2048 by 1536 pixels · FOV: 45 degrees
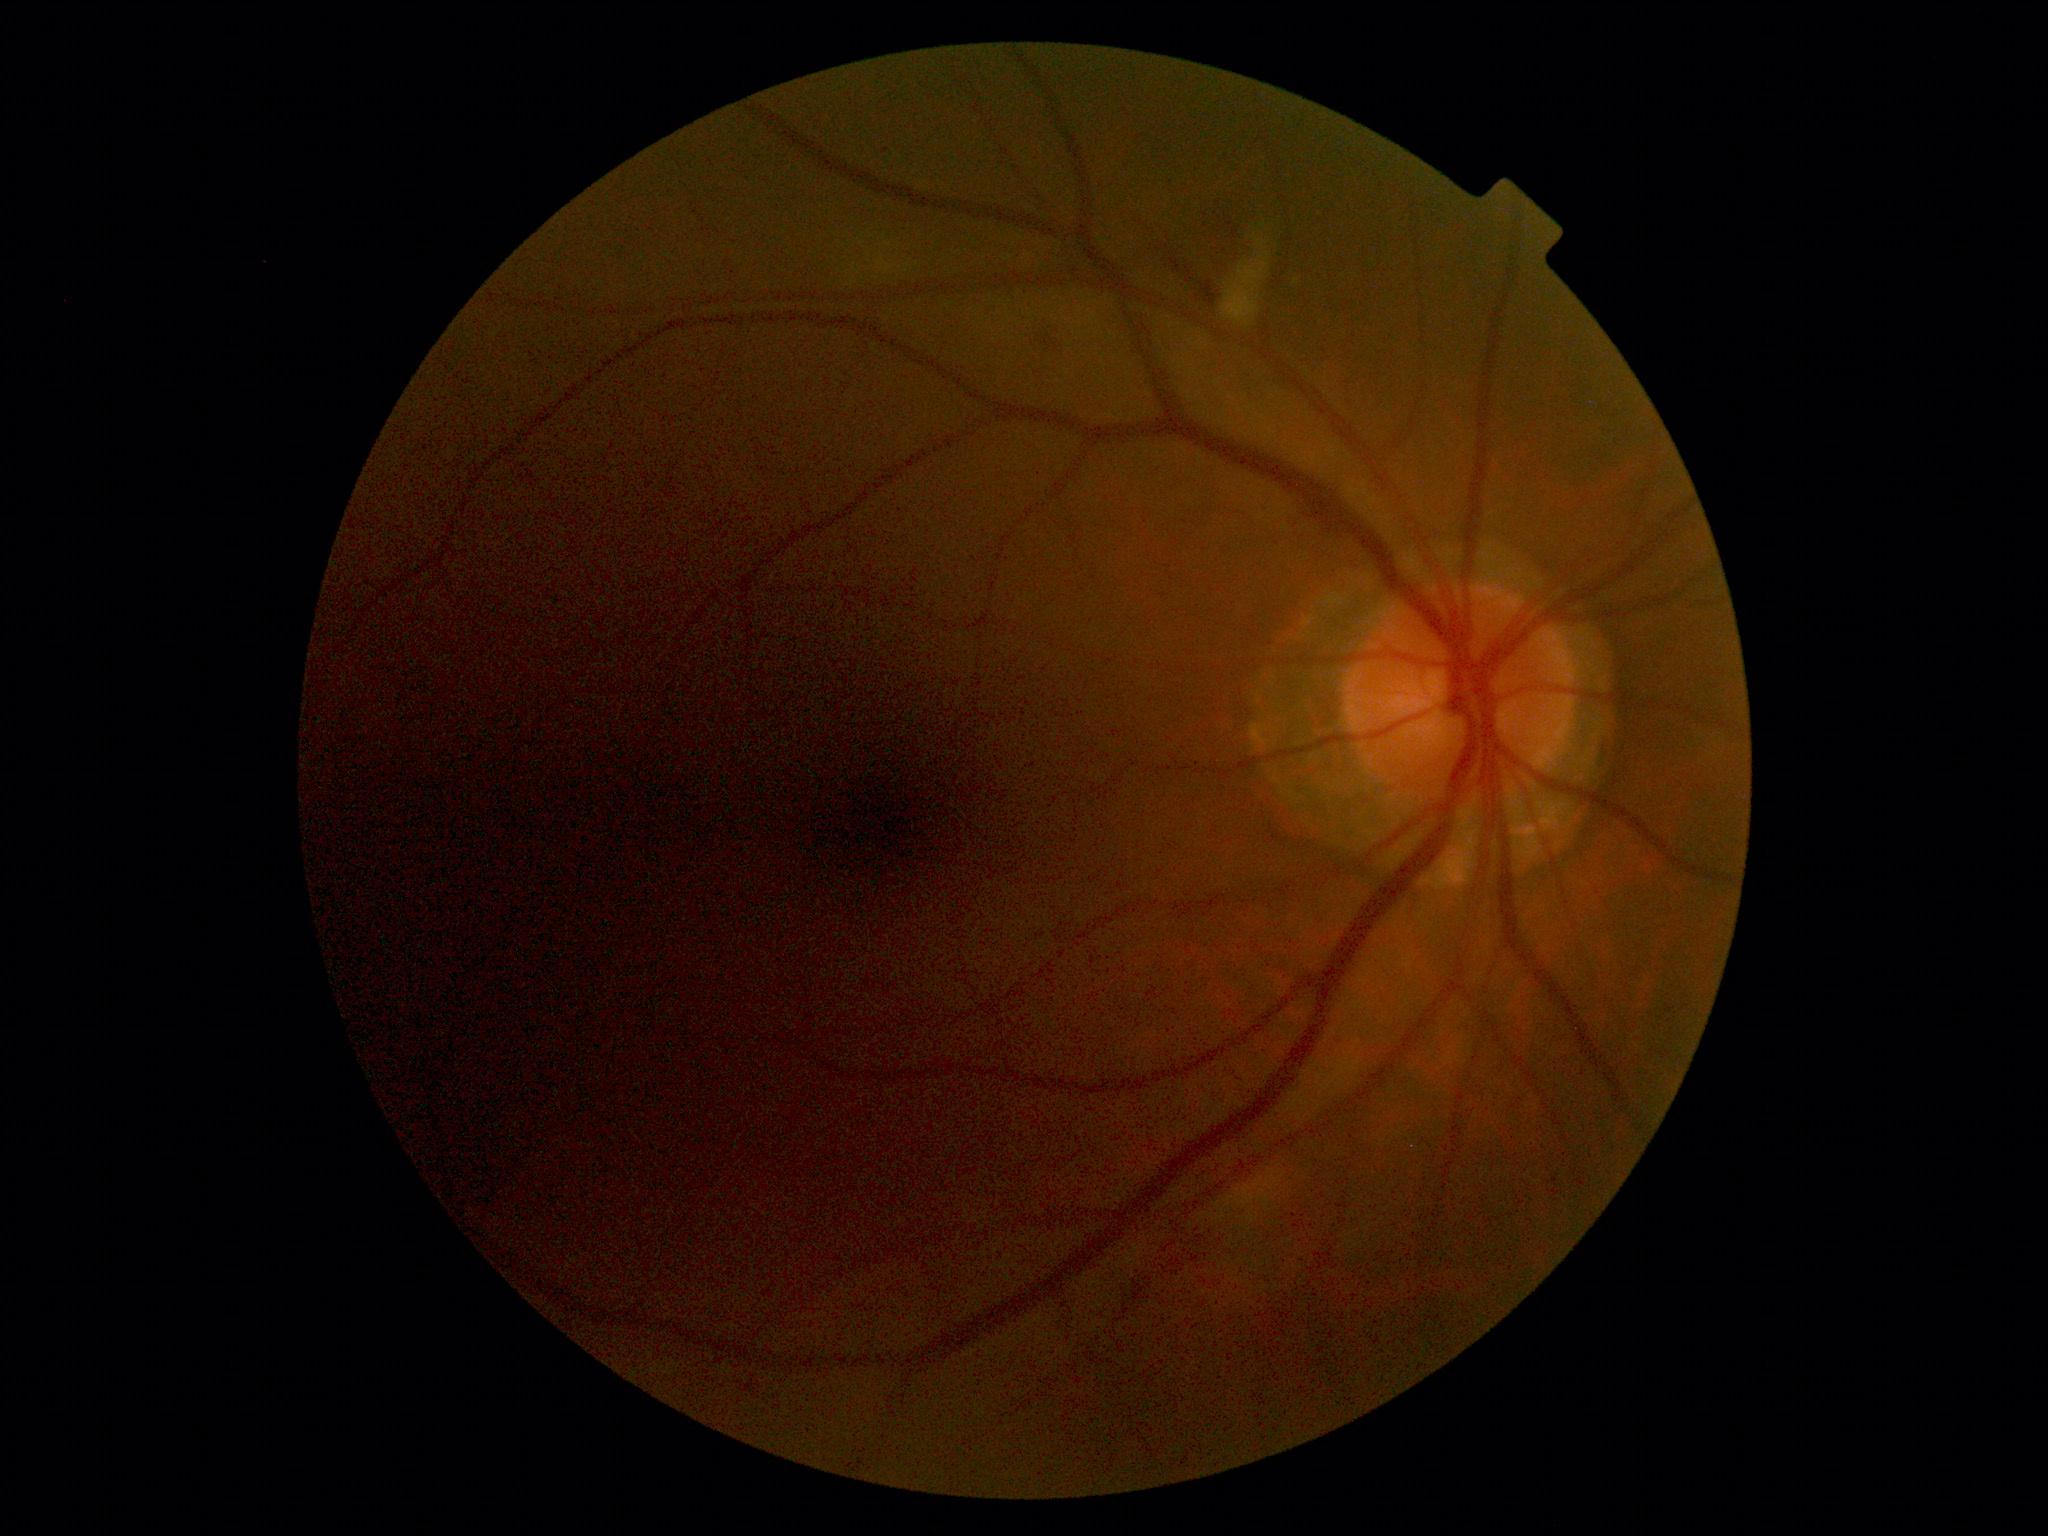

DR = moderate NPDR (grade 2)
DR class = non-proliferative diabetic retinopathy